2212x1659, color fundus photograph:
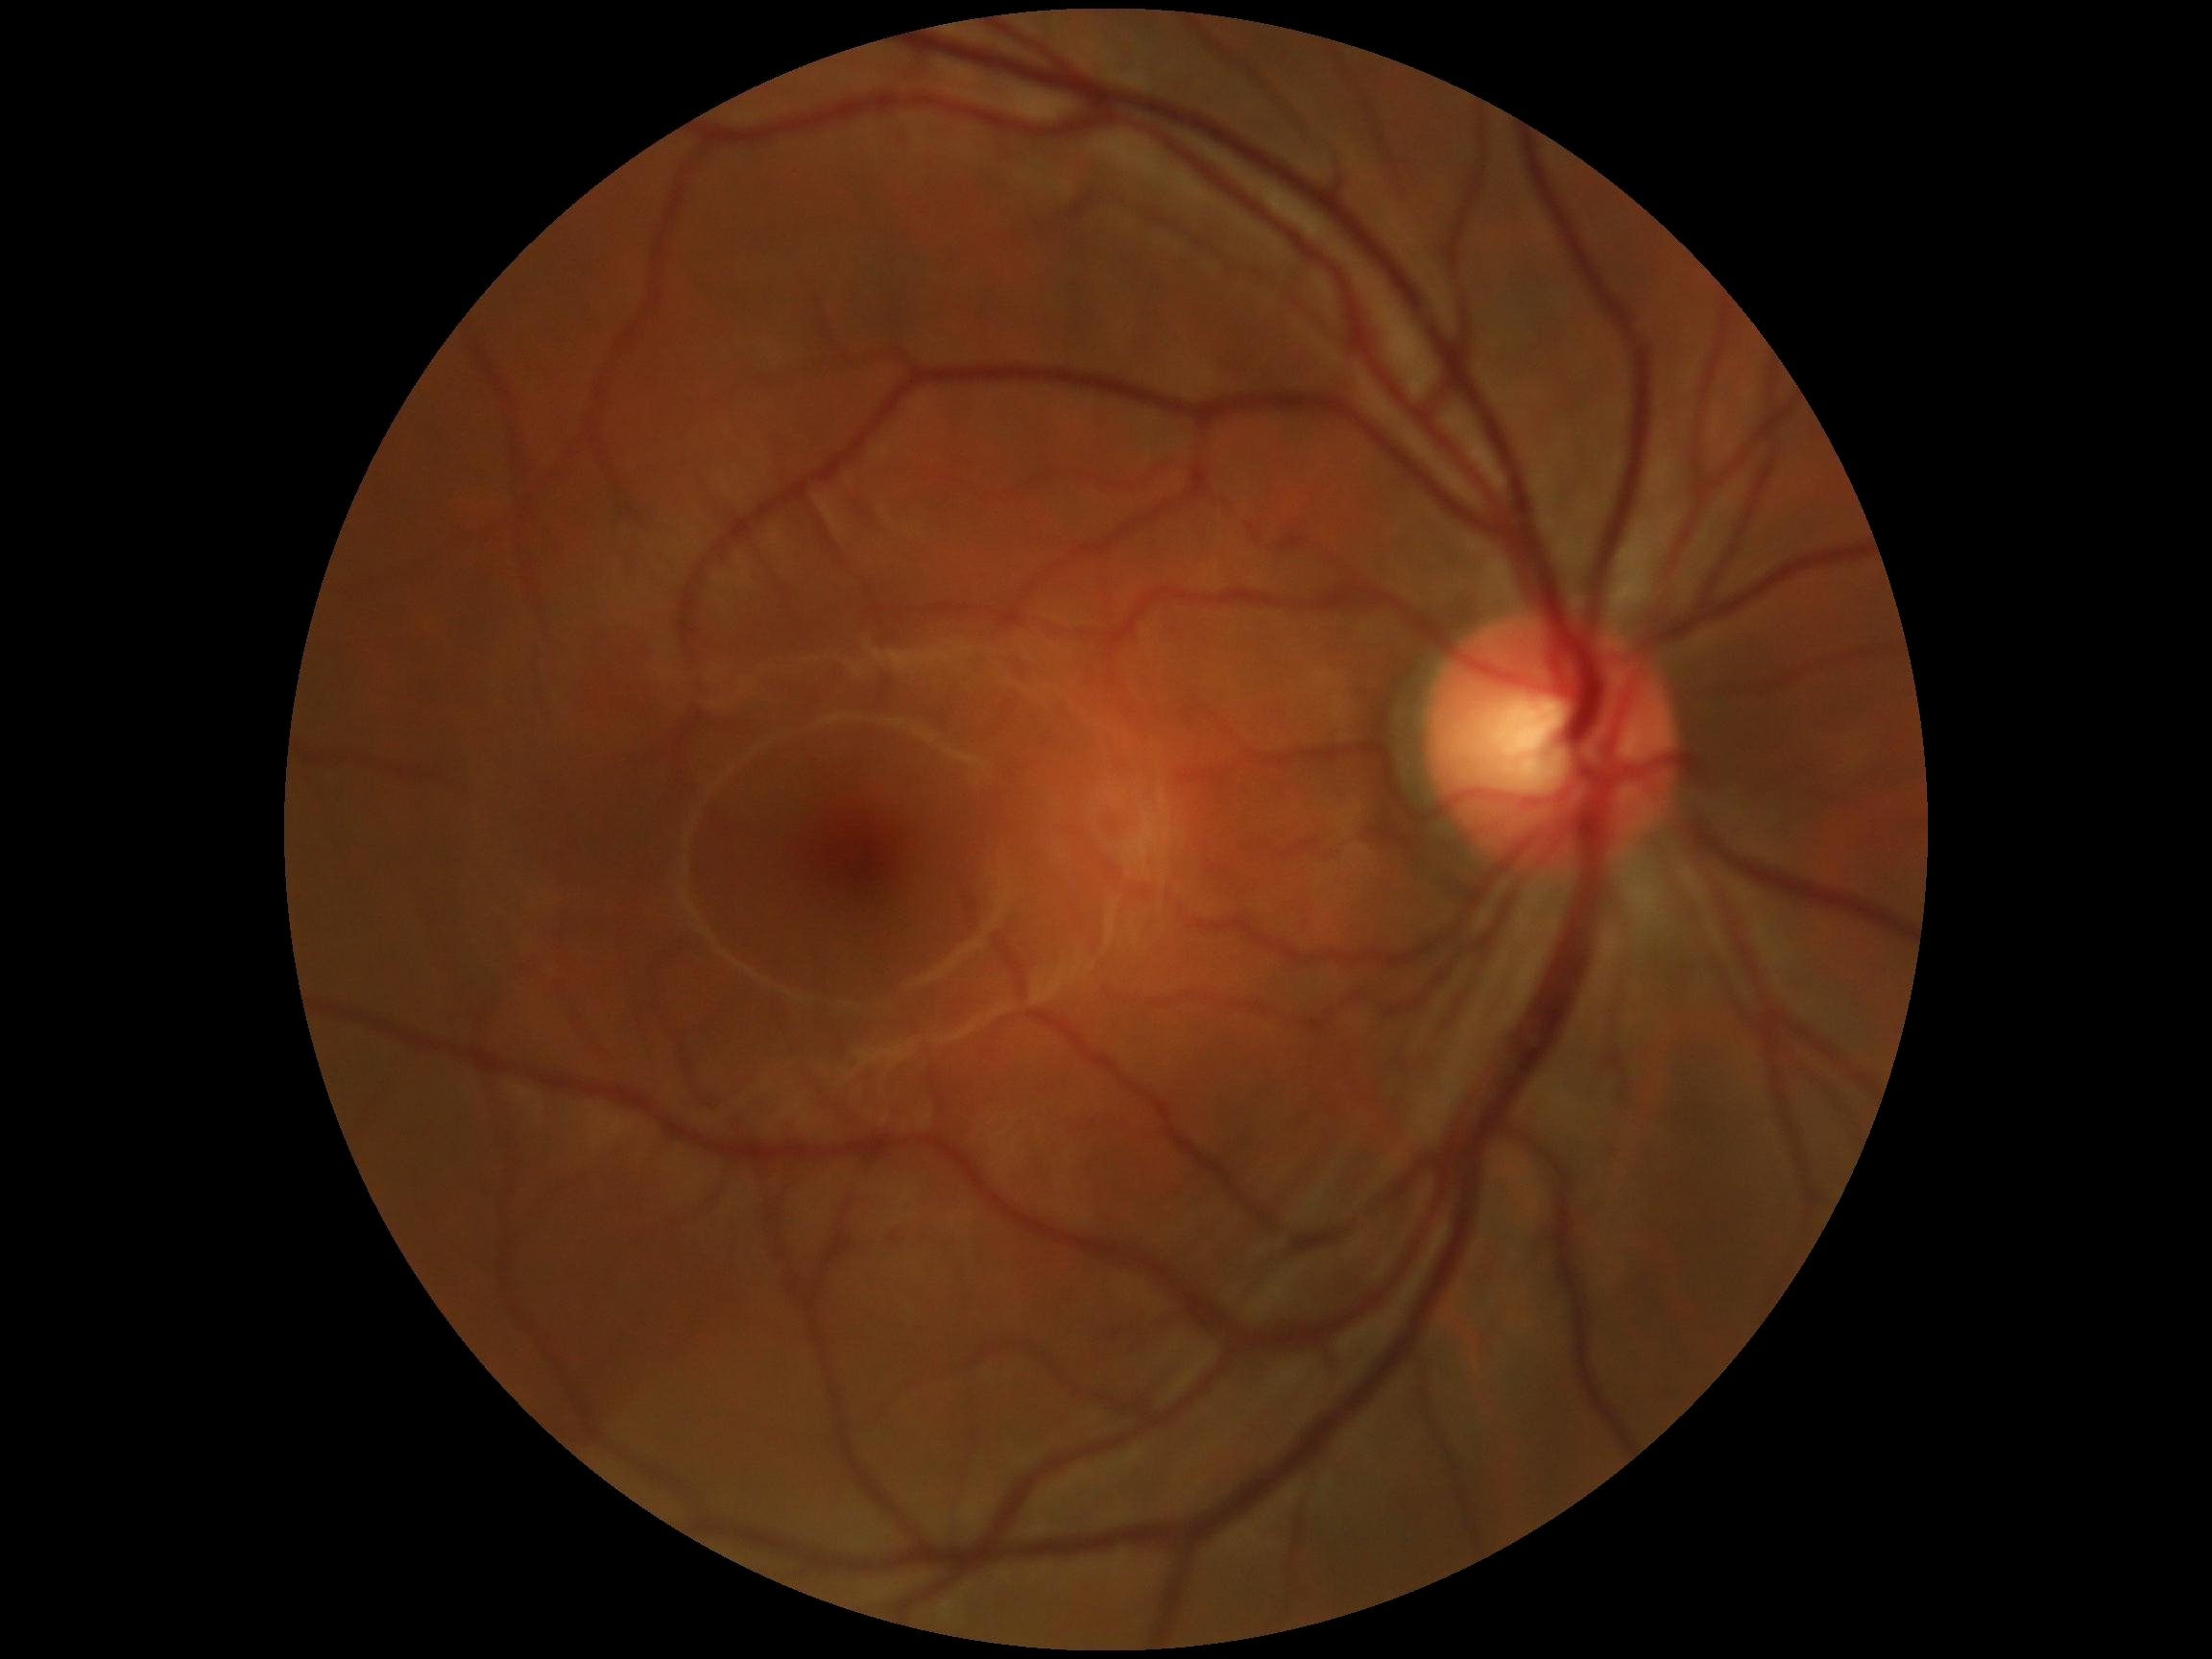 diabetic retinopathy (DR): grade 0 (no apparent retinopathy)